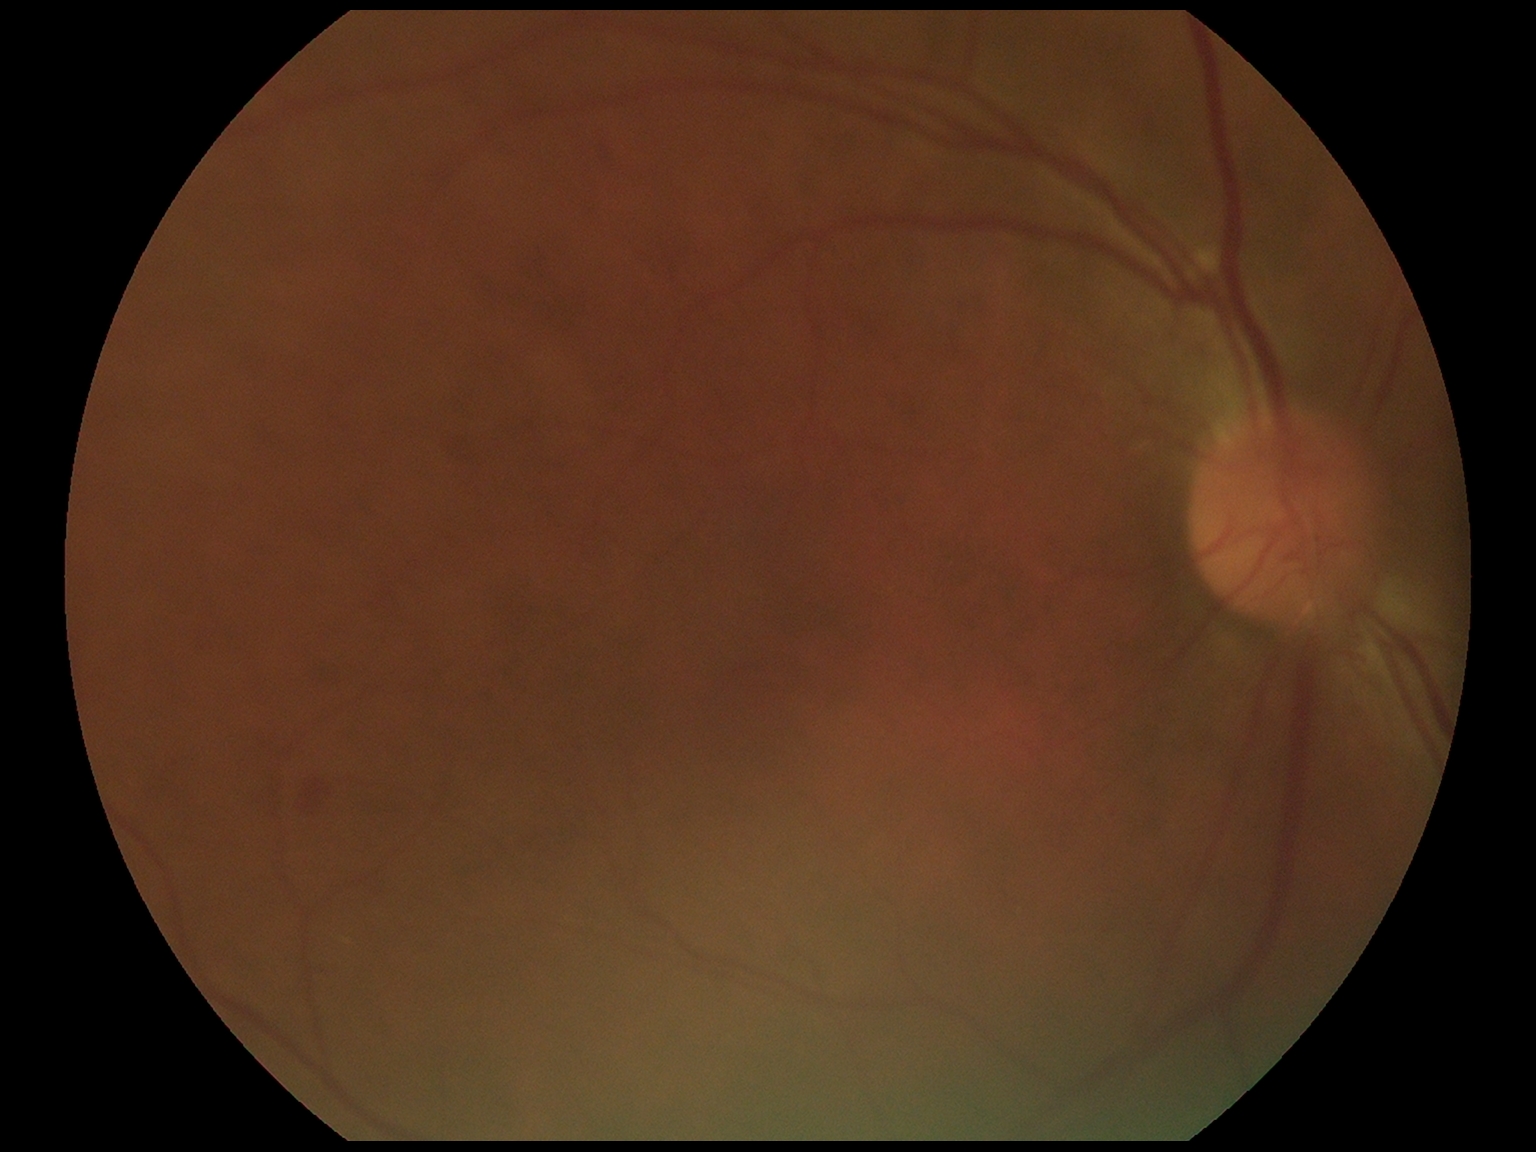 Retinopathy is 2.